Fundus photo
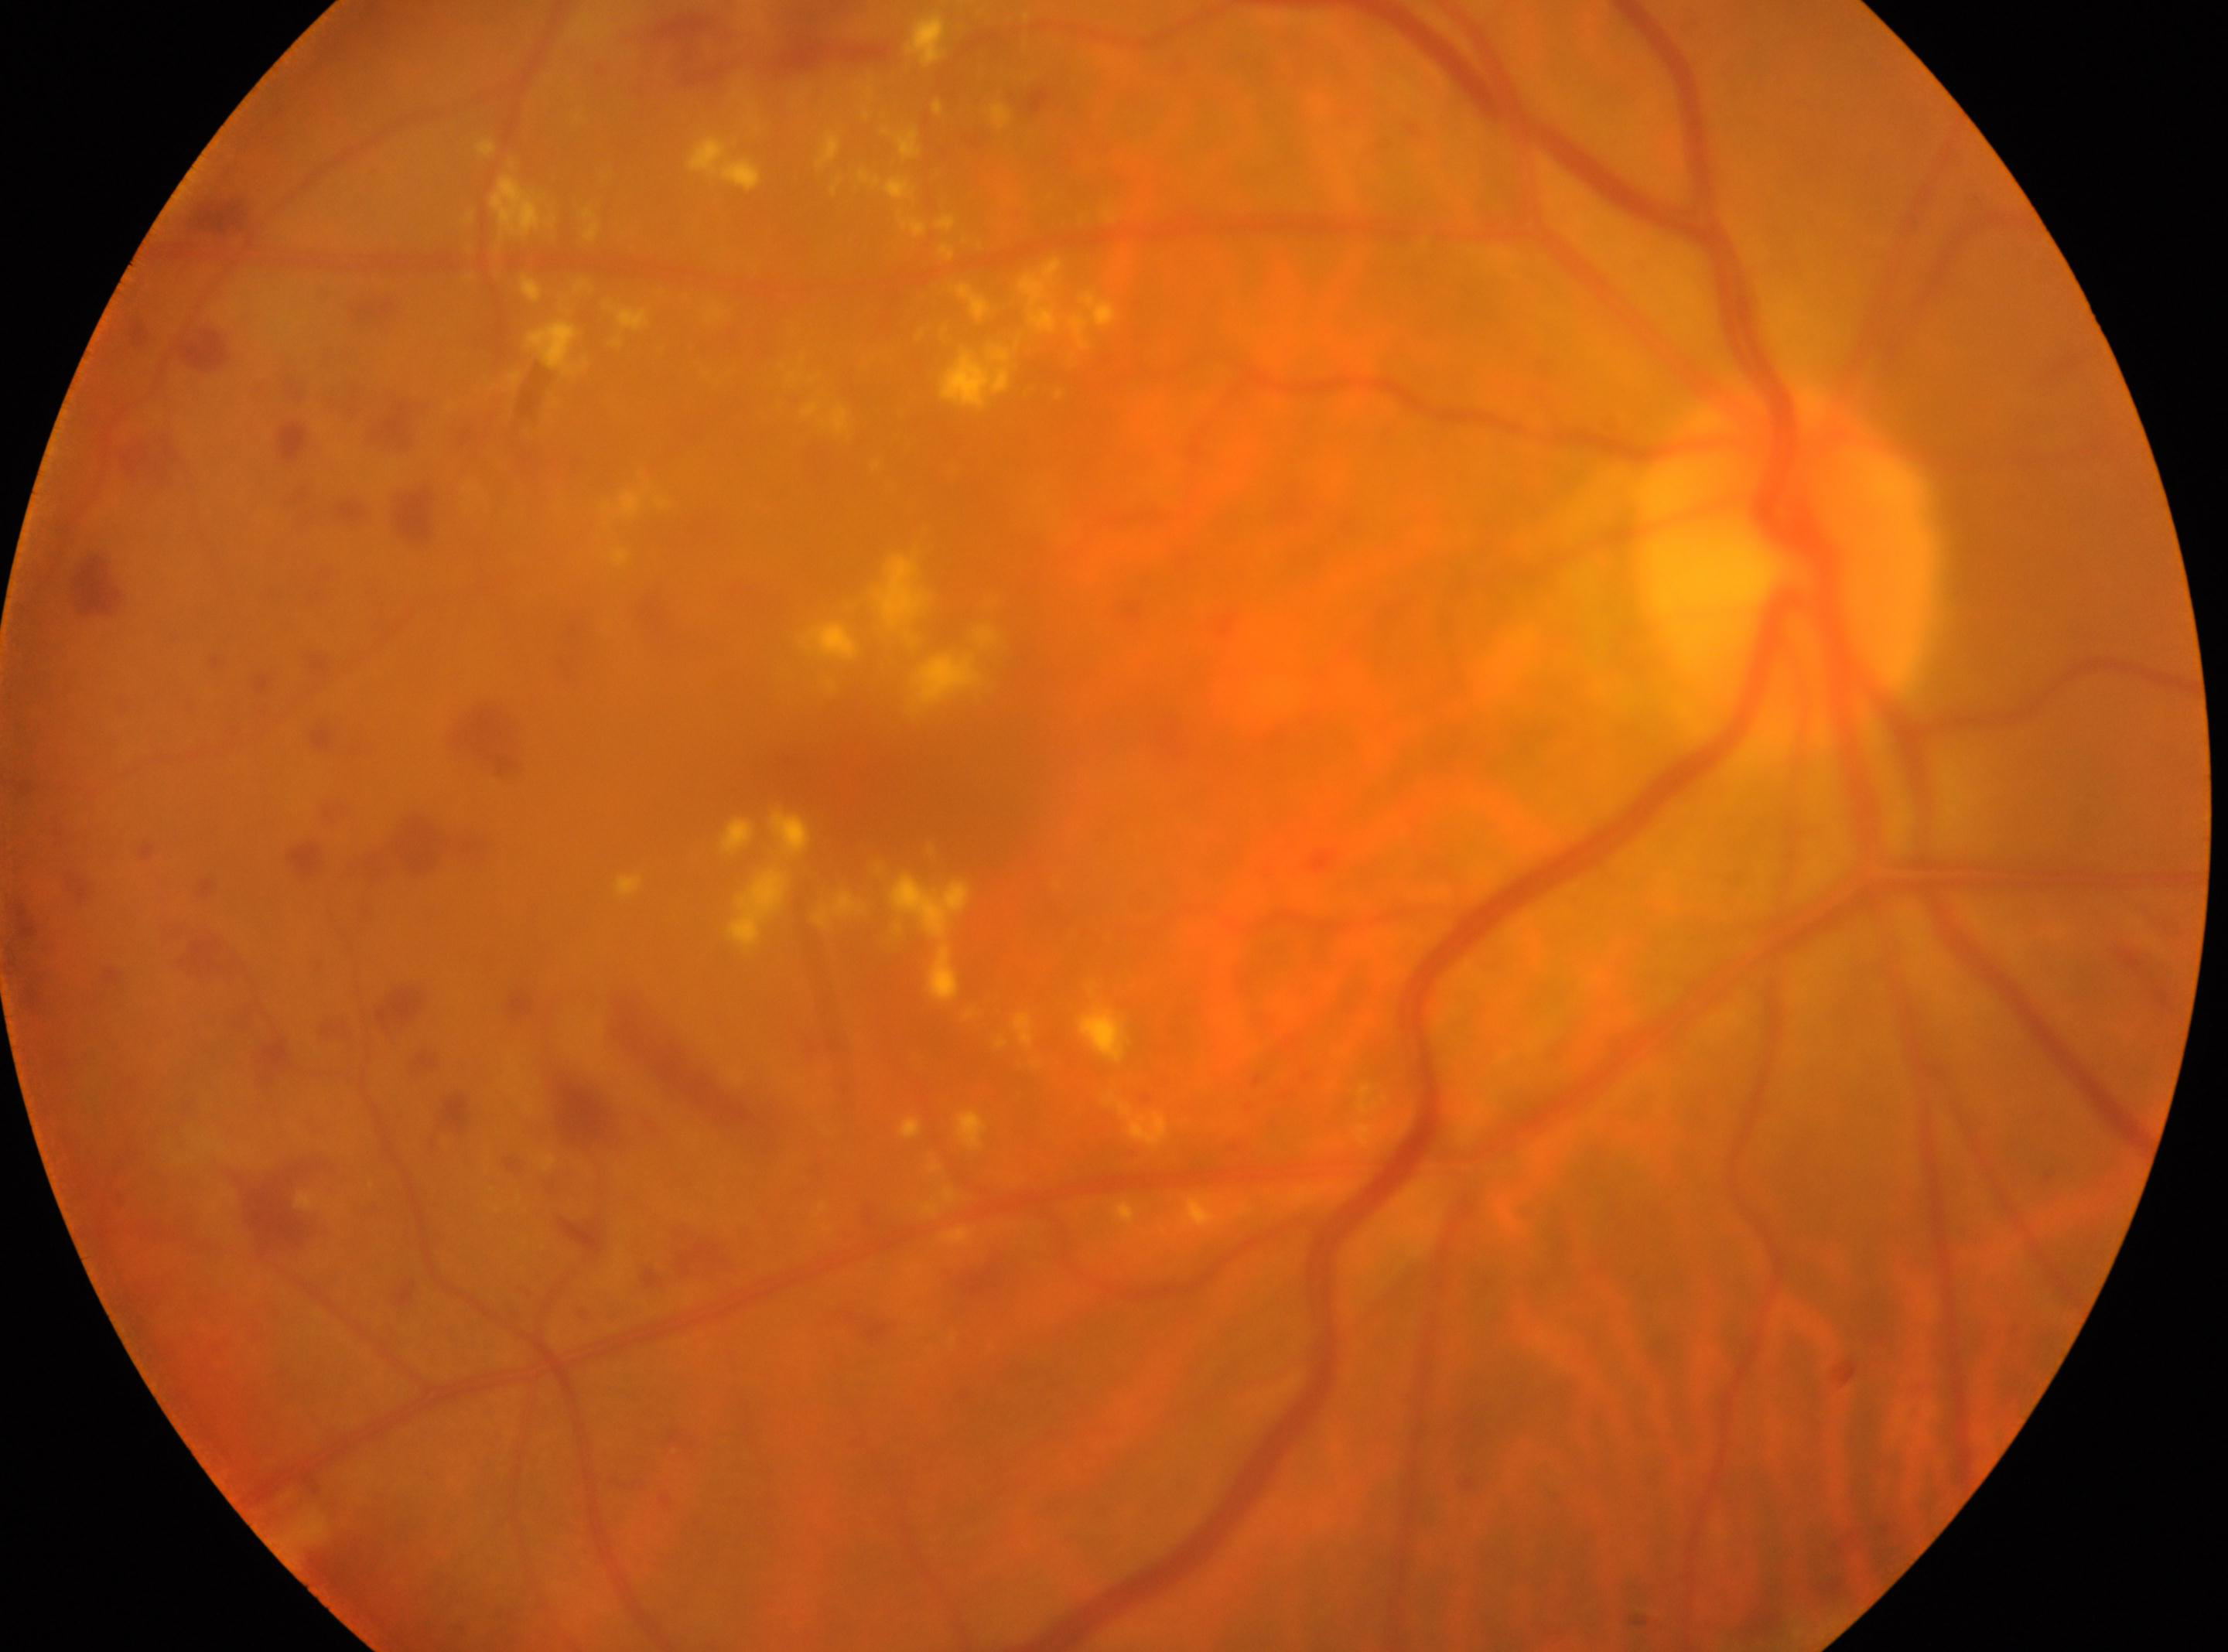 The image shows the right eye. DR severity: moderate NPDR (grade 2). The optic disc is at x=1787, y=561. Fovea located at x=857, y=775.